1932x1923 · FOV: 45 degrees.
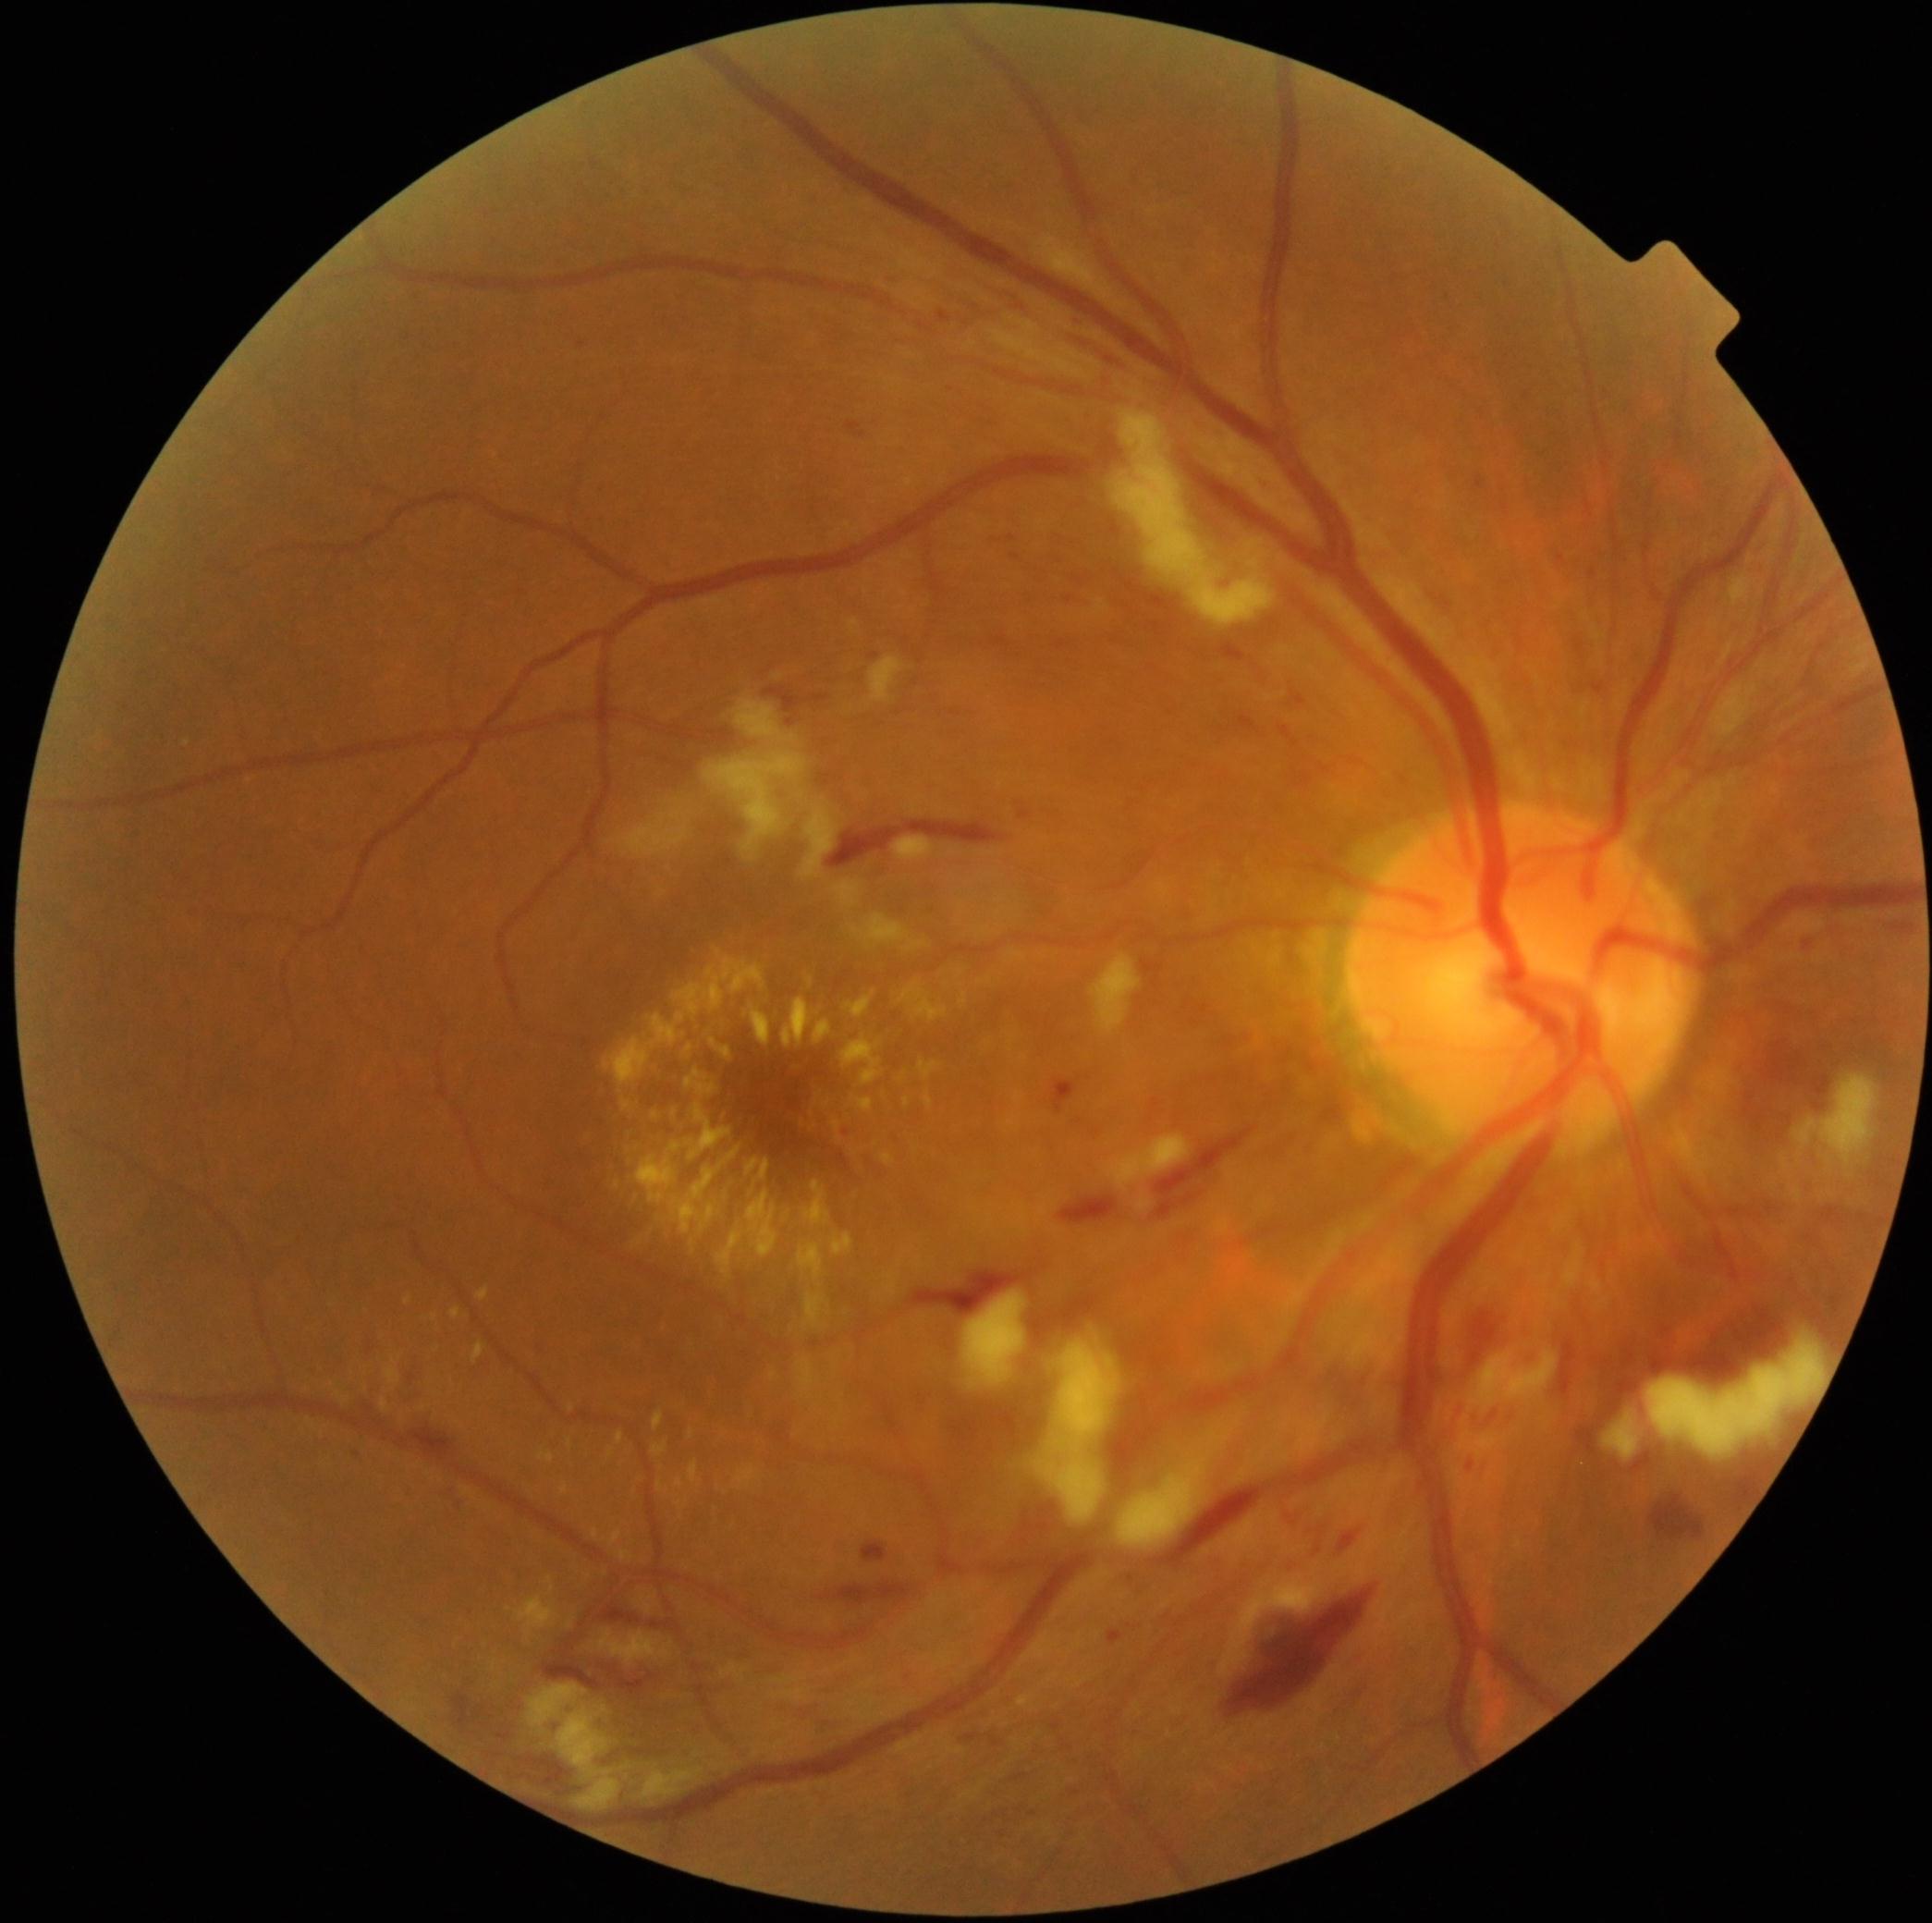

{"partial": true, "dr_grade": 3, "dr_grade_name": "severe NPDR", "lesions": {"ex": [[962, 994, 968, 1005], [560, 1484, 568, 1493], [746, 1192, 779, 1257], [654, 1411, 665, 1431], [476, 1287, 489, 1301], [783, 998, 813, 1047], [798, 1243, 825, 1280], [452, 1308, 461, 1319], [807, 977, 813, 986], [852, 1096, 874, 1113], [684, 1044, 693, 1058], [832, 1233, 854, 1255], [715, 949, 721, 957]], "ex_small": [[646, 1036], [660, 1220]]}}